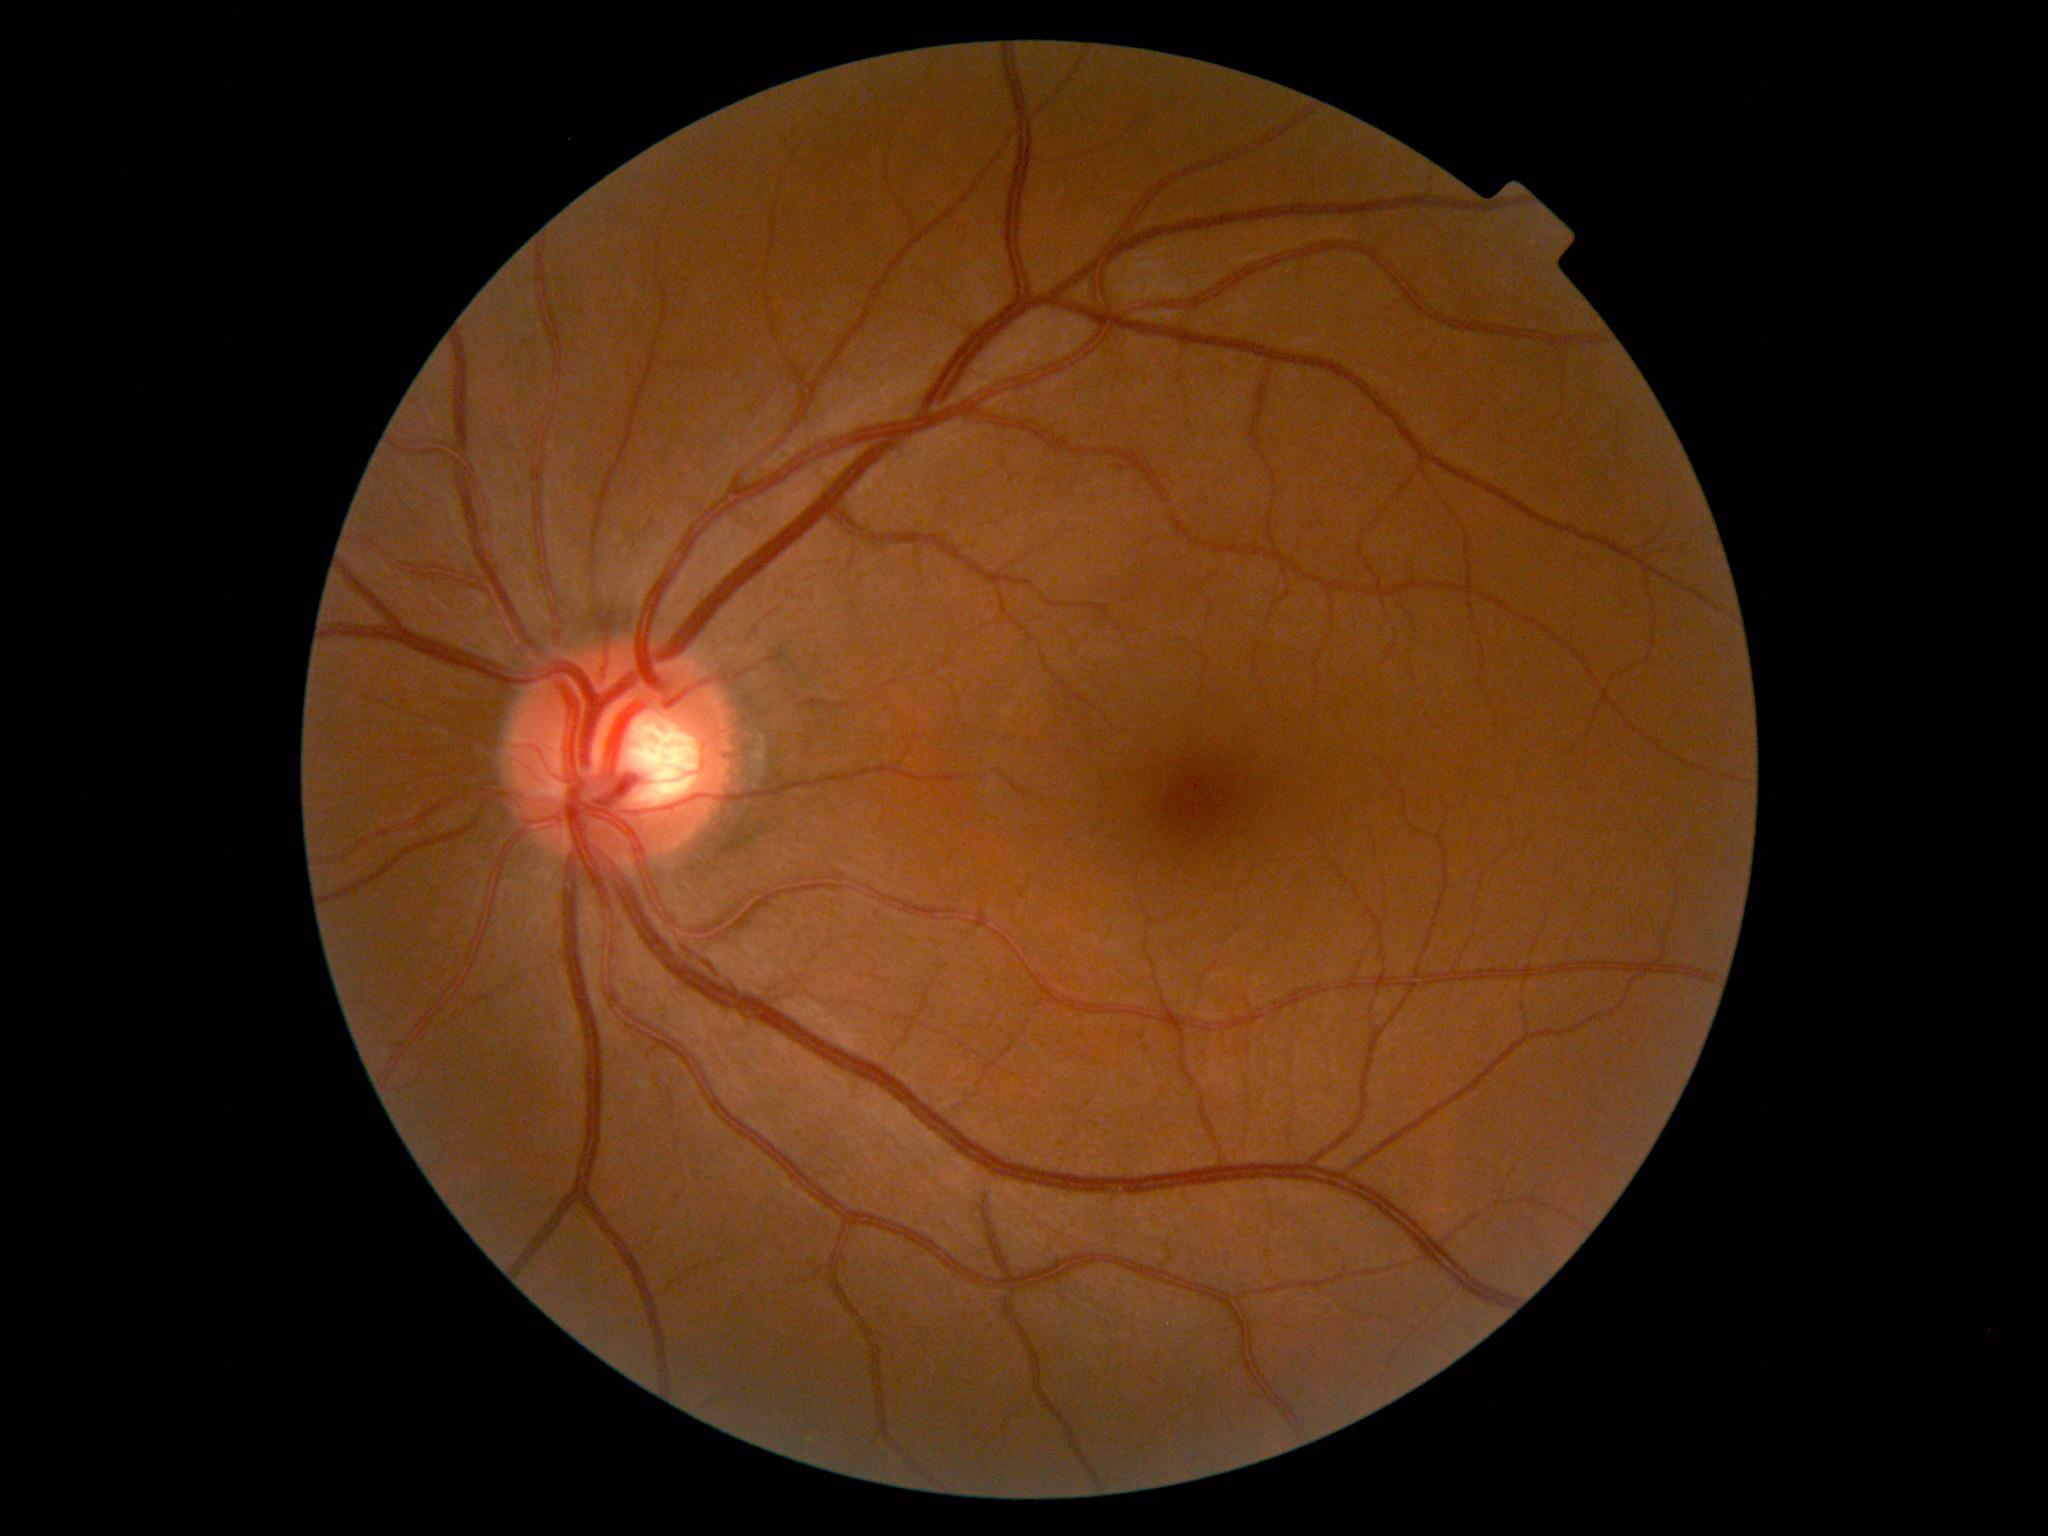 Retinopathy grade is 0 (no apparent retinopathy).
No apparent diabetic retinopathy.